1932 by 1910 pixels. 45° field of view. CFP — 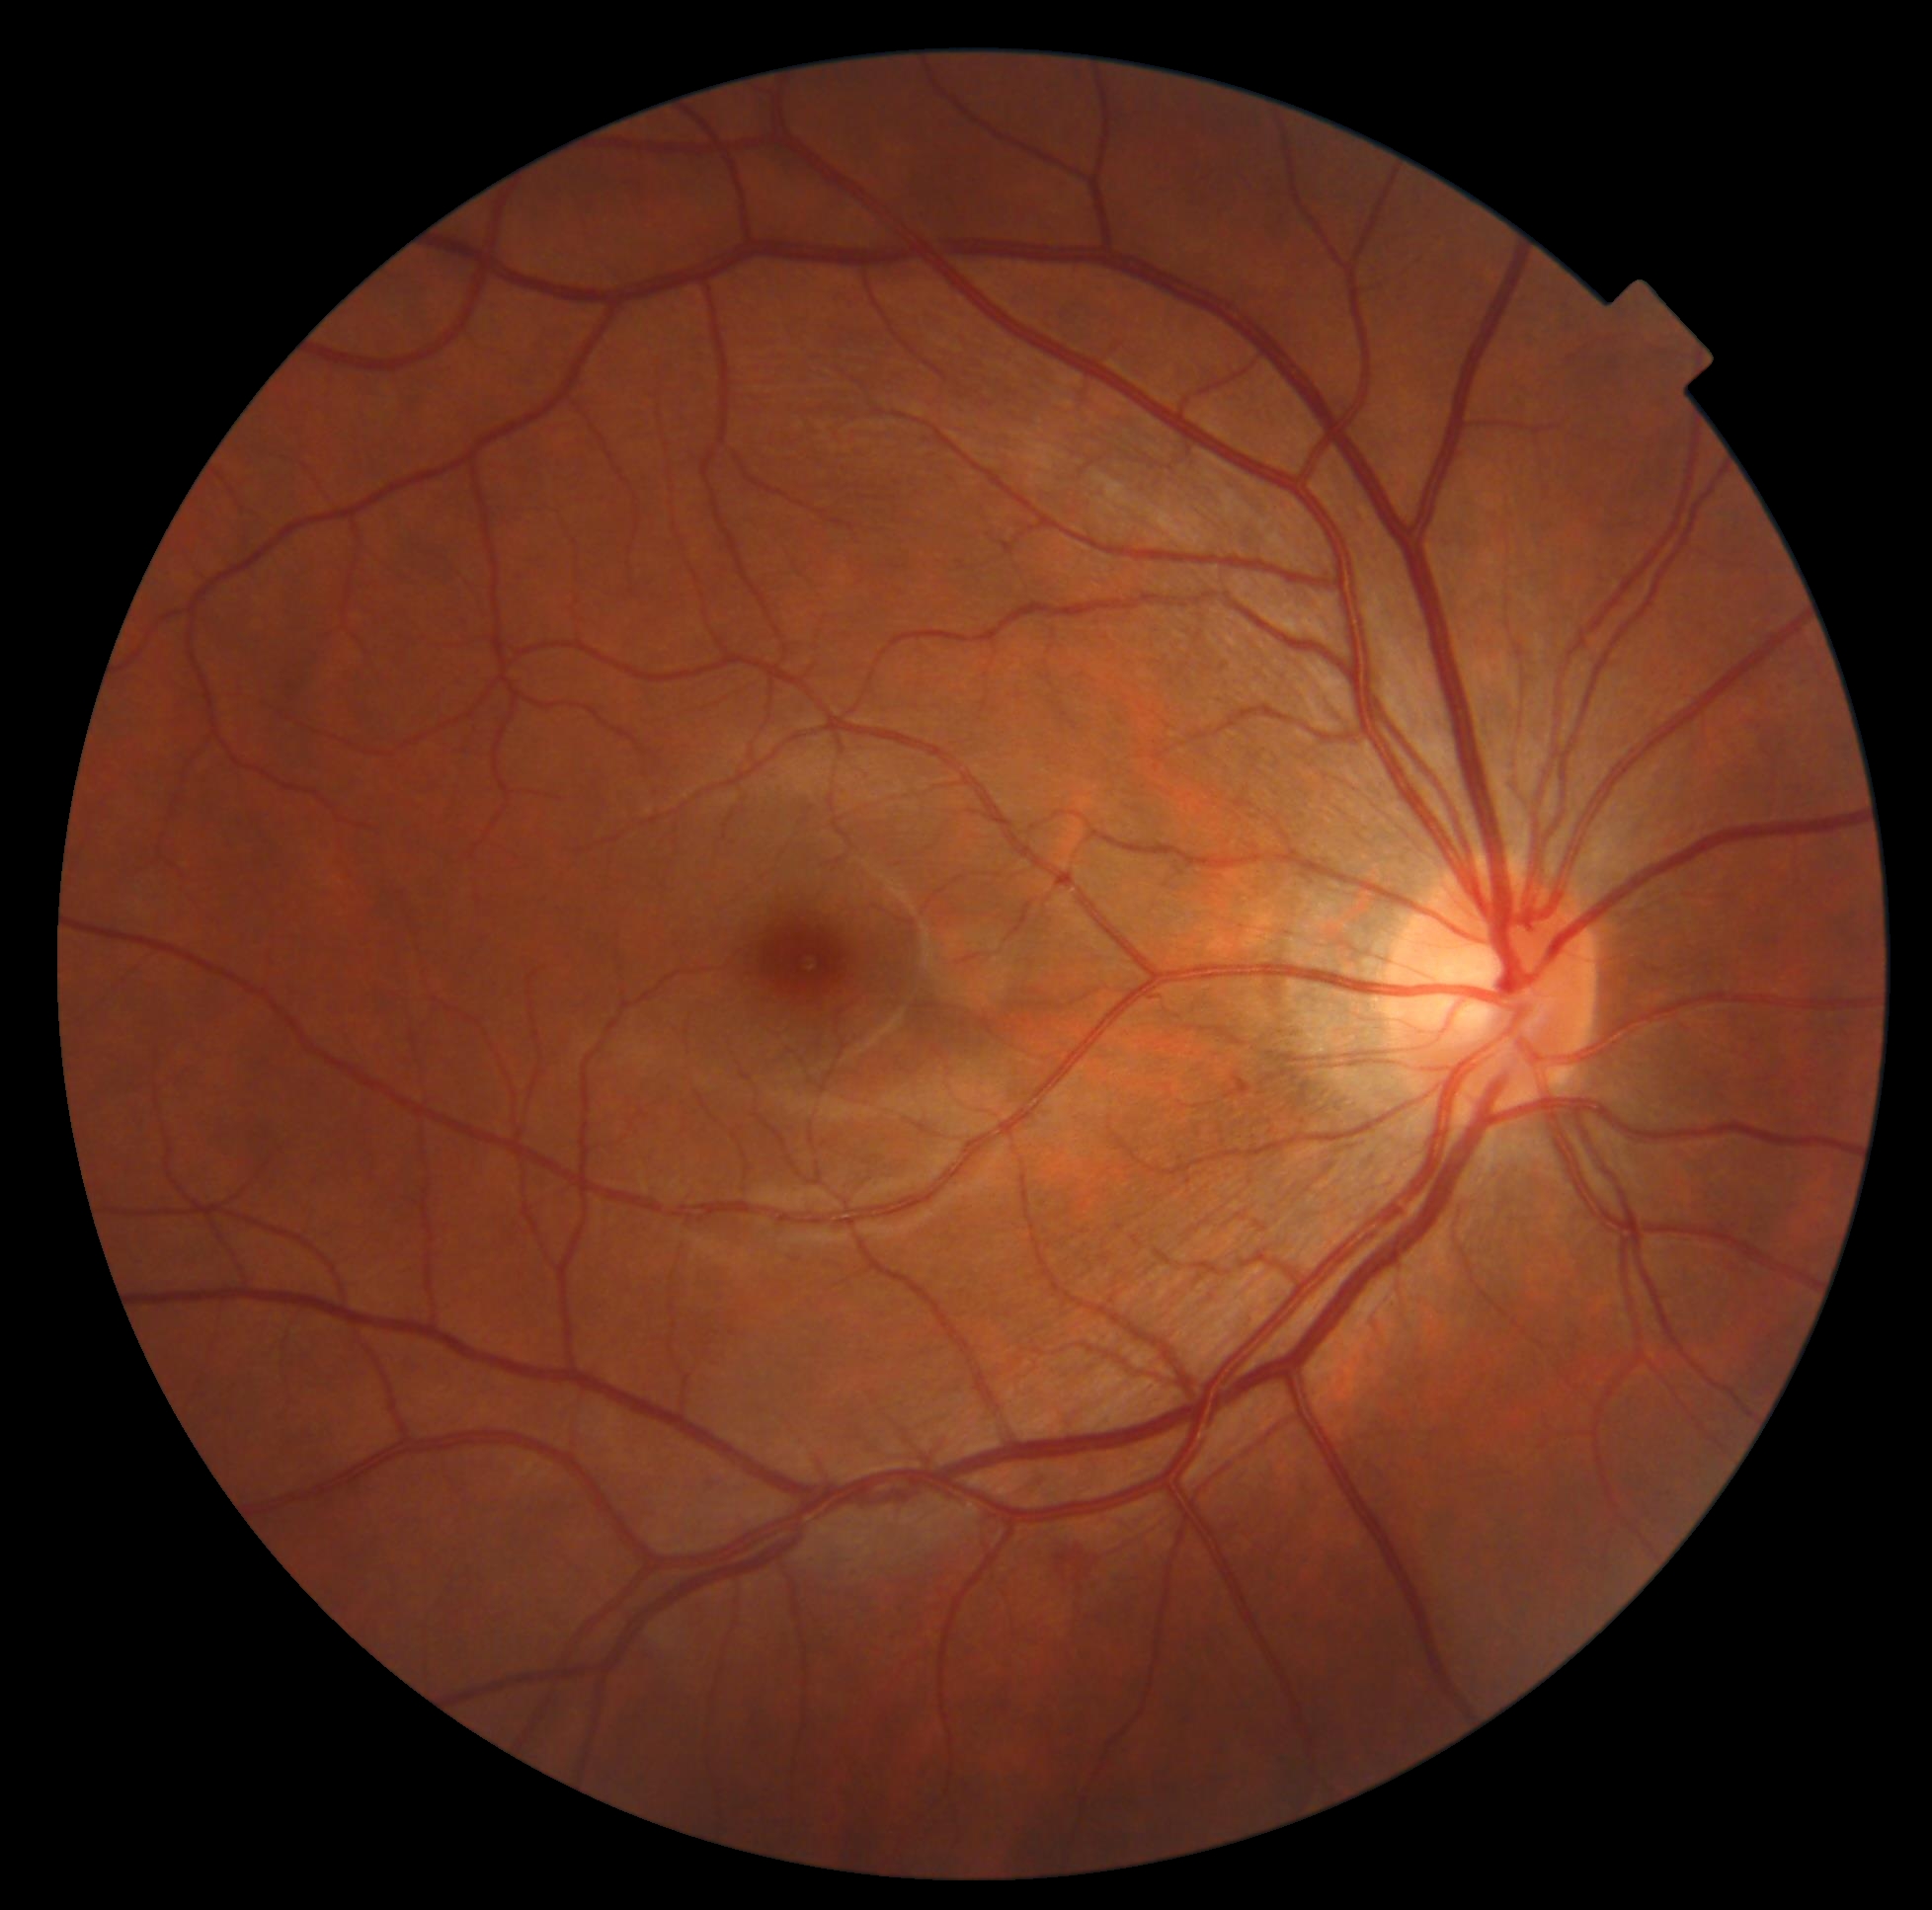
diabetic retinopathy (DR)@moderate NPDR (grade 2).